Camera: NIDEK AFC-230:
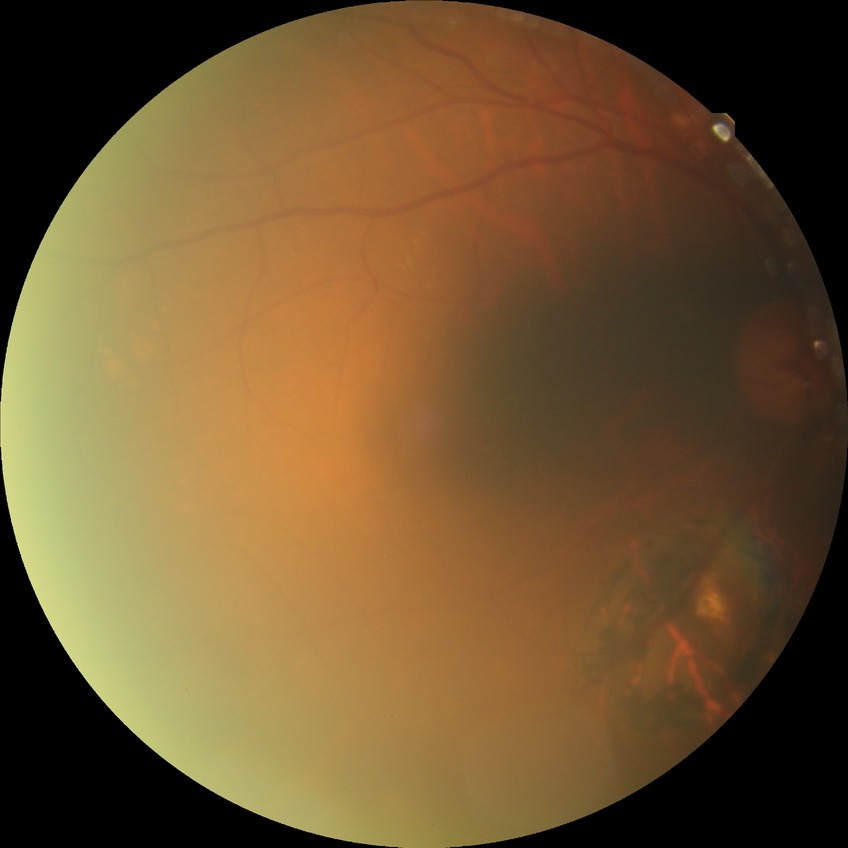   davis_grade: NDR (no diabetic retinopathy)